NIDEK AFC-230.
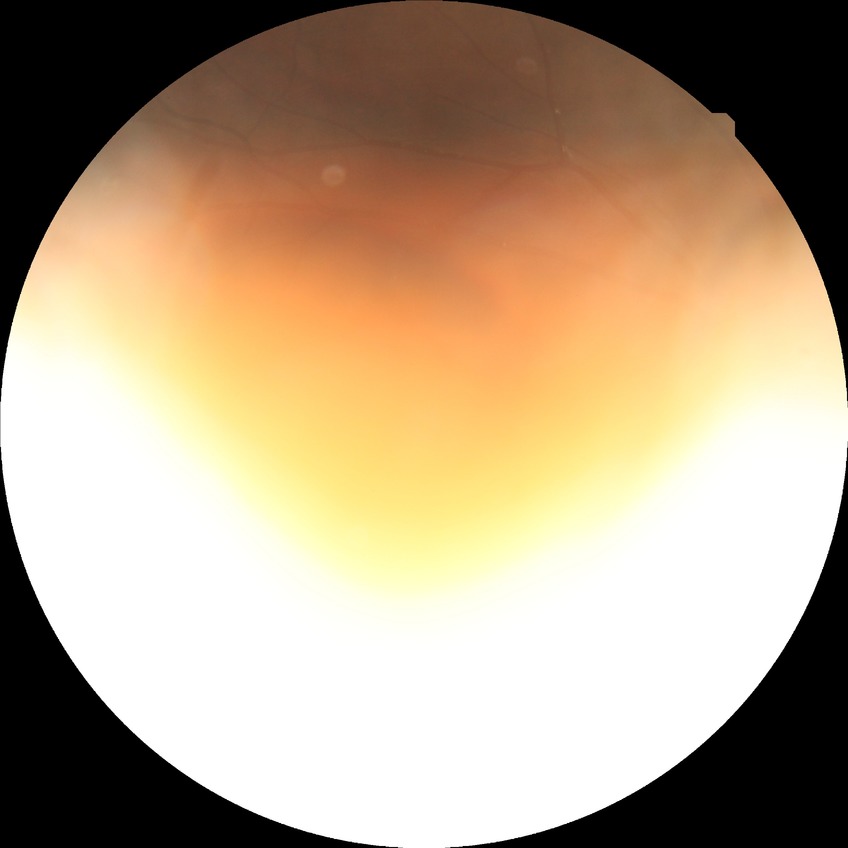

Modified Davis grading is no diabetic retinopathy.